Wide-field contact fundus photograph of an infant: 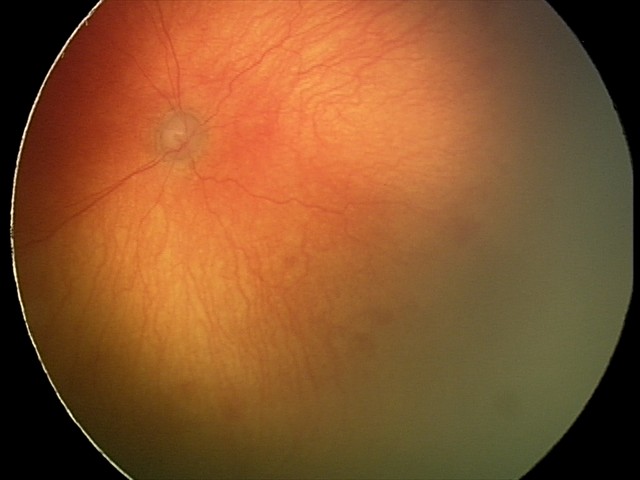

Screening diagnosis: aggressive ROP (A-ROP) | plus disease.